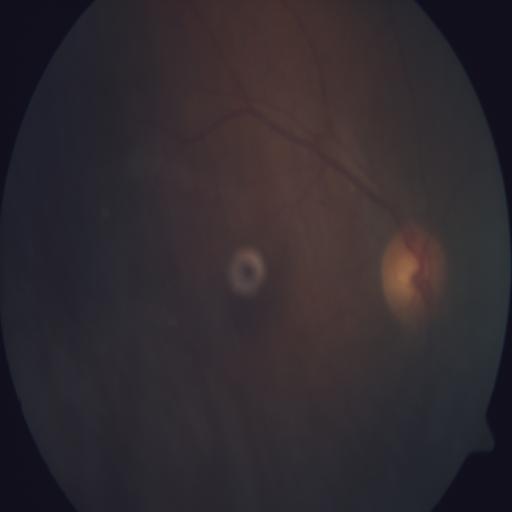 Diagnoses: media haze (MH).